FOV: 45 degrees: 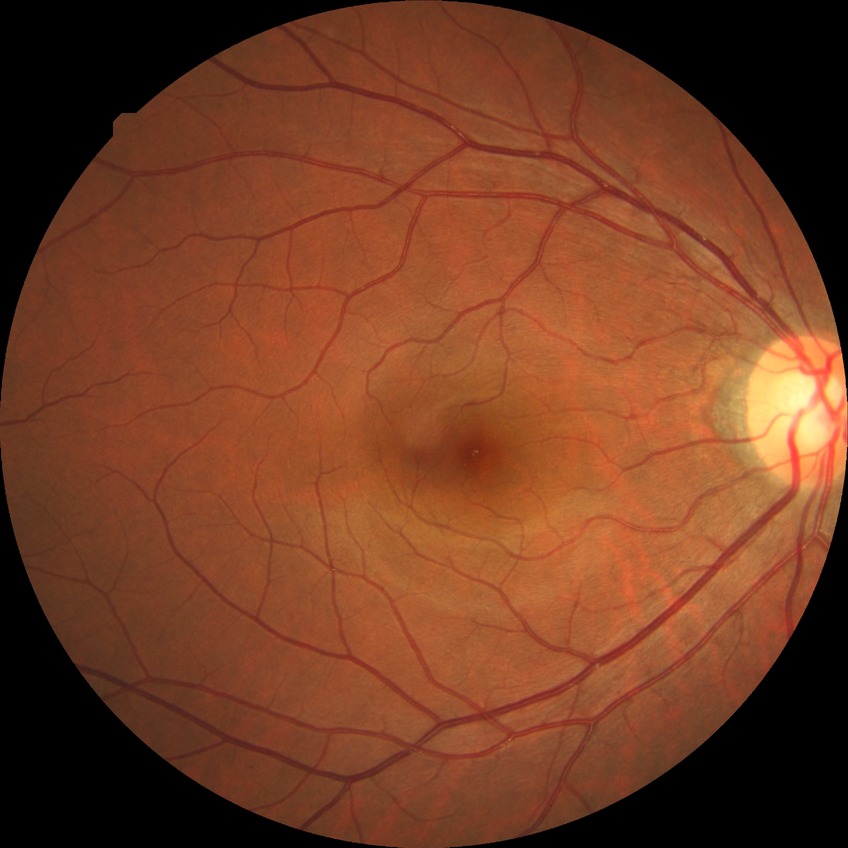

Diabetic retinopathy (DR) is no diabetic retinopathy (NDR).